2352x1568.
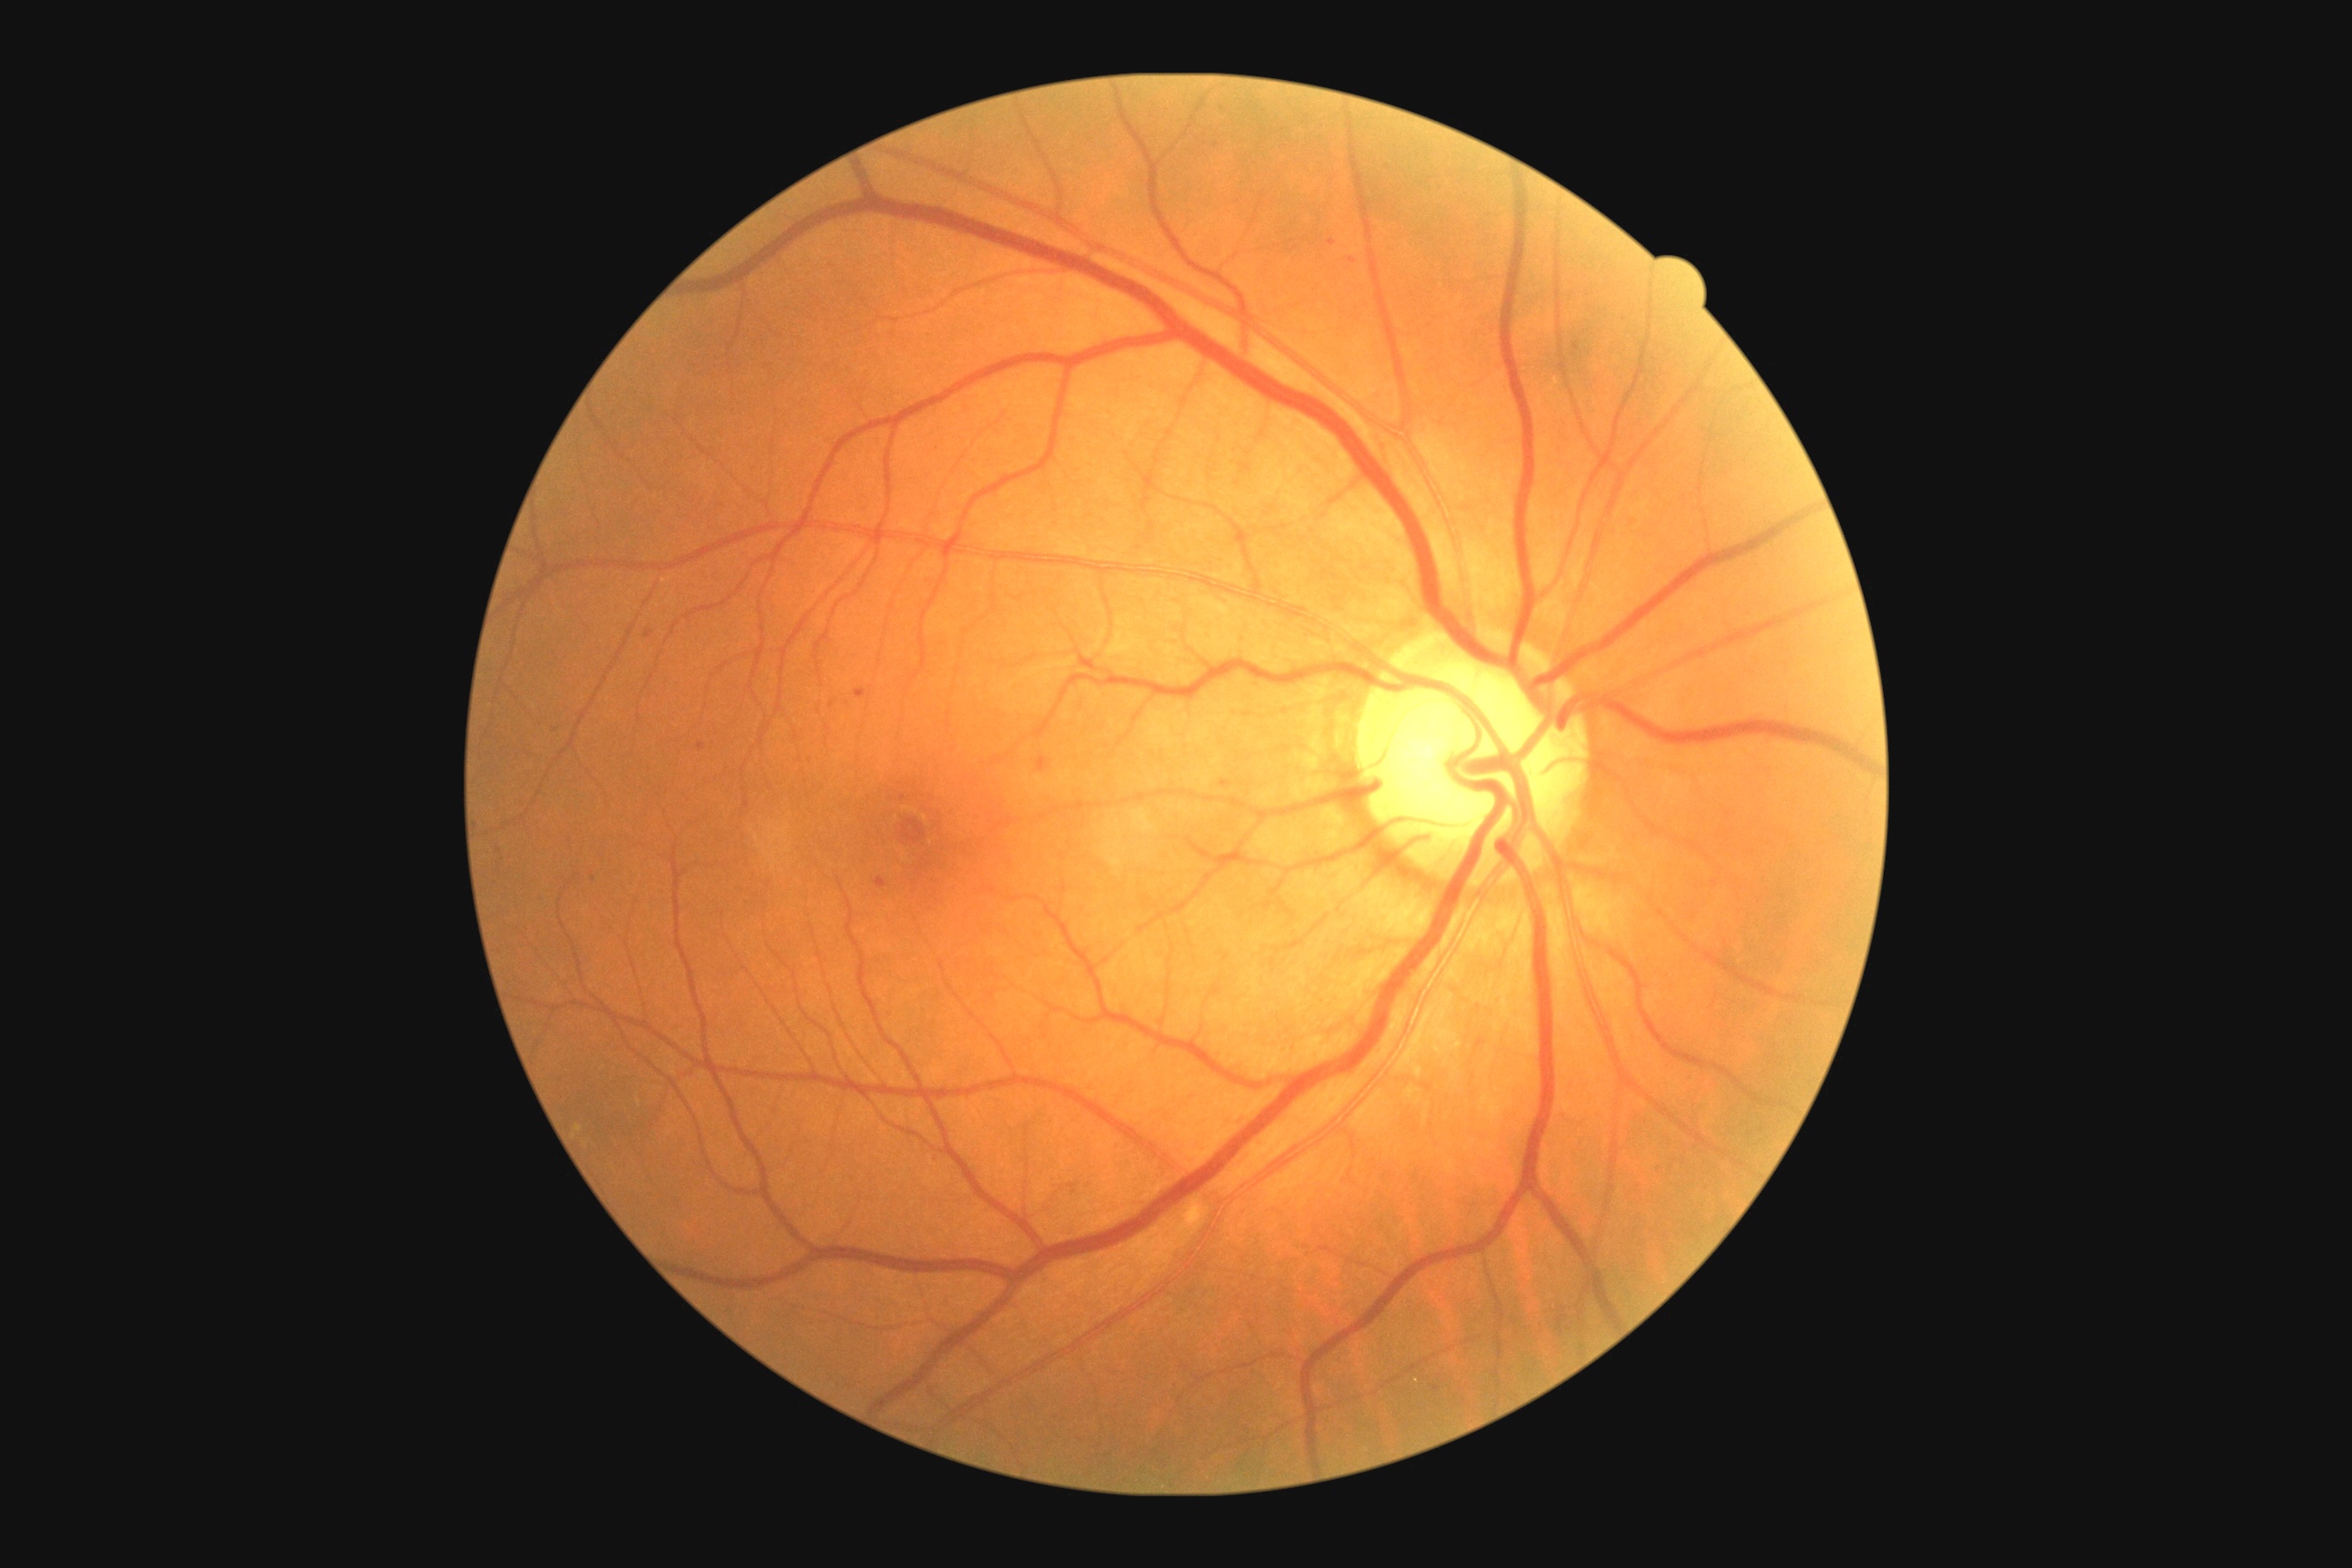
DR class: non-proliferative diabetic retinopathy.
Diabetic retinopathy grade: 2.